Infant wide-field fundus photograph · acquired on the Natus RetCam Envision · 1440x1080px: 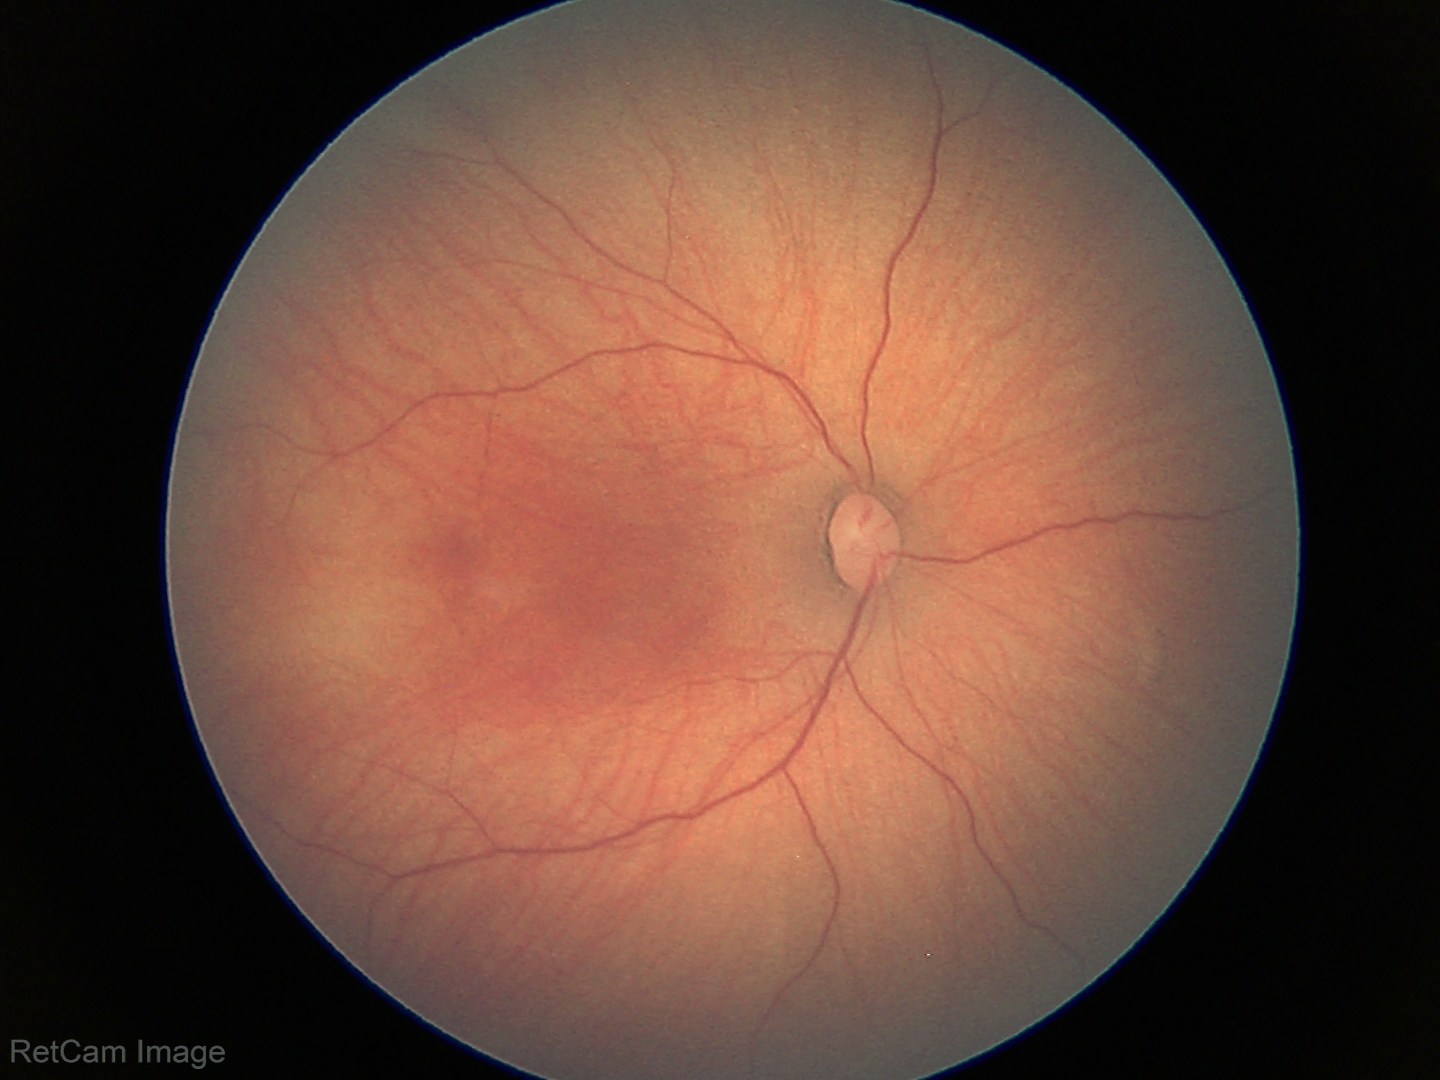 Impression: physiological retinal finding.